2048 x 1536 pixels · color fundus image
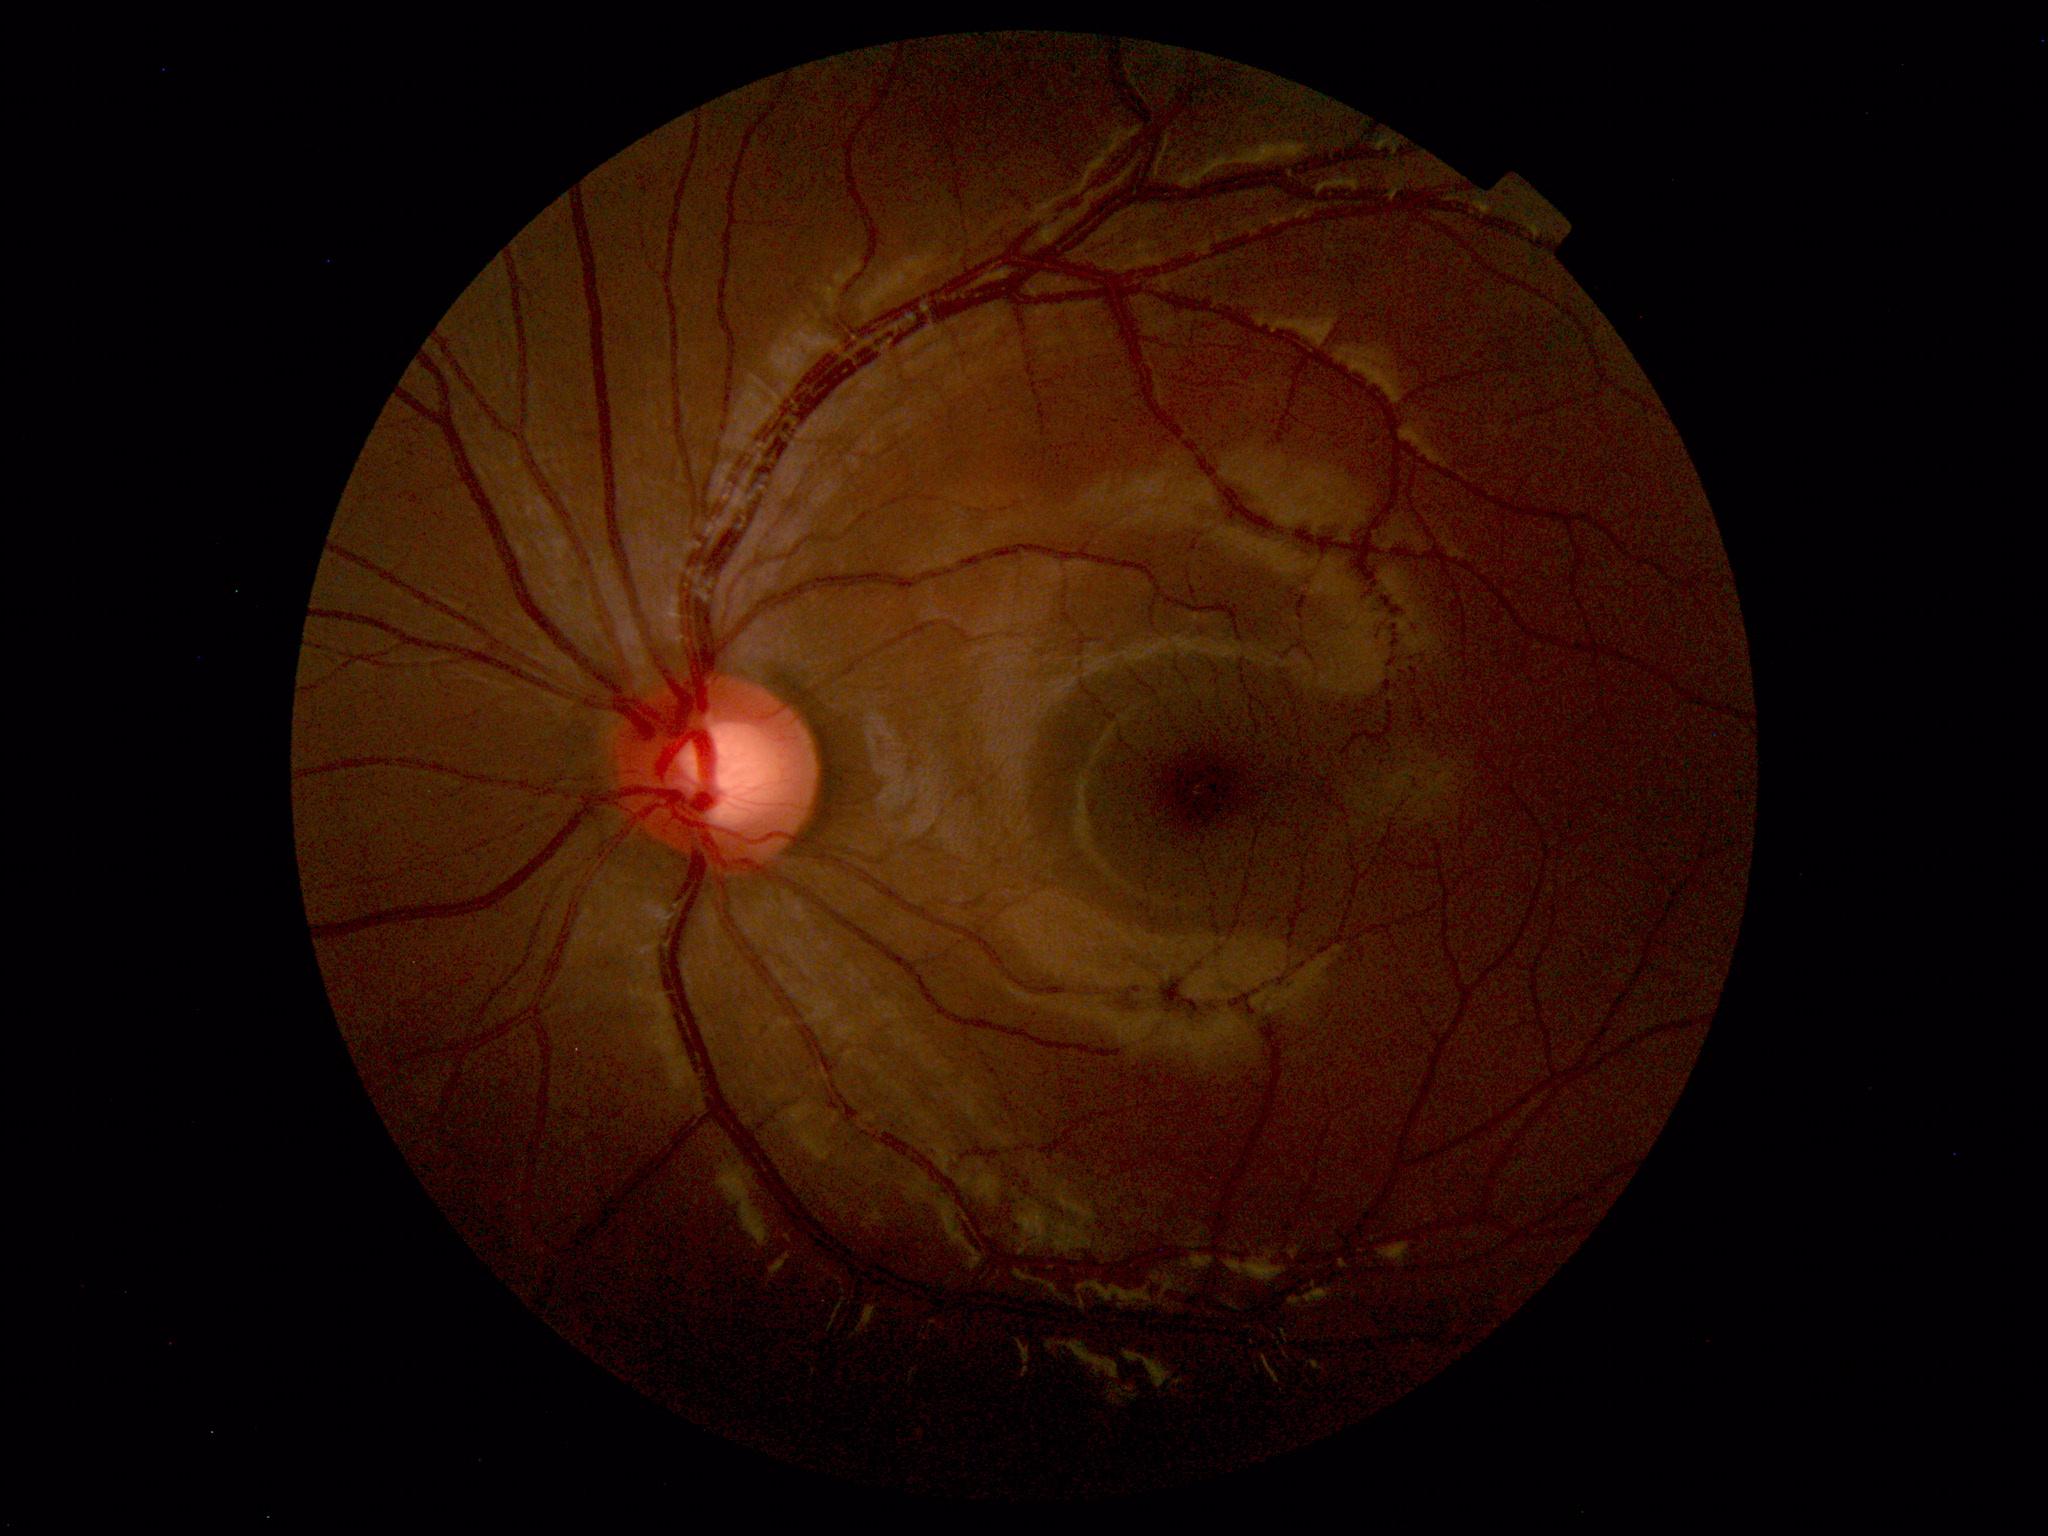

No retinal pathology identified.